Nonmydriatic, 848x848px, retinal fundus photograph, NIDEK AFC-230: 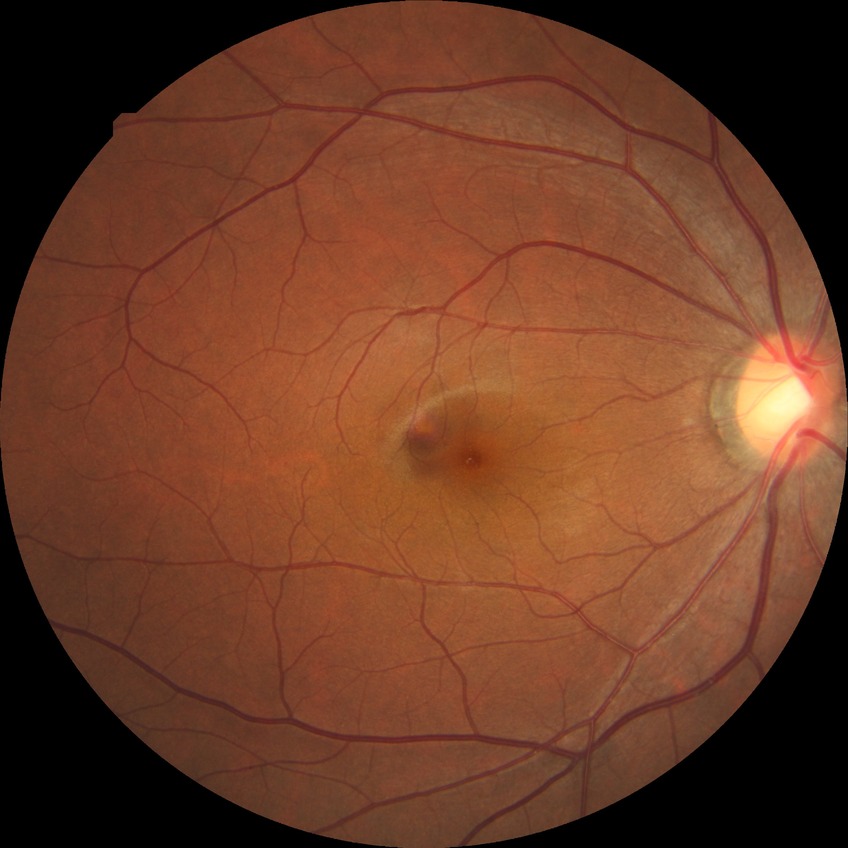 {"davis_grade": "no diabetic retinopathy (NDR)"}